NIDEK AFC-230 fundus camera:
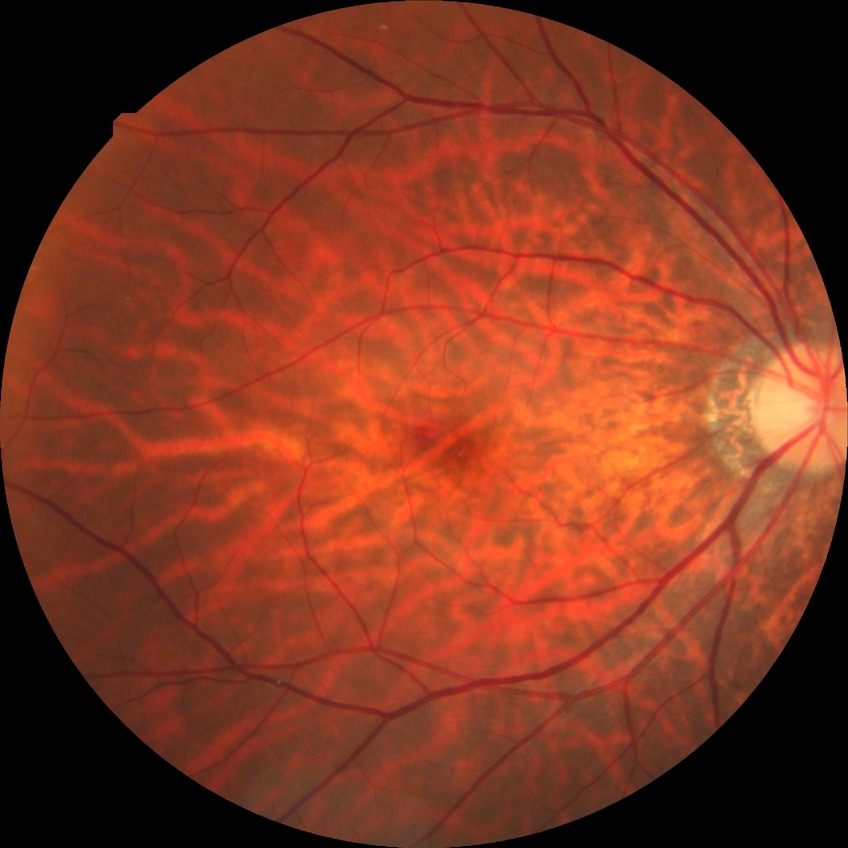 diabetic retinopathy (DR): no diabetic retinopathy (NDR).